412 x 310 pixels.
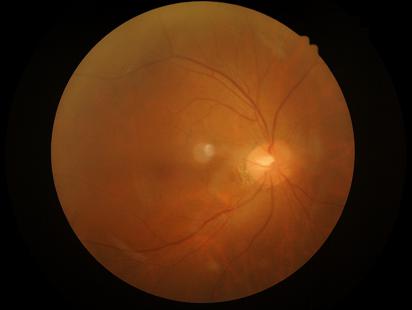
Illumination and color are suboptimal.
Good dynamic range.
No noticeable blur.
Overall image quality is poor.